1240x1240px. Pediatric retinal photograph (wide-field). Phoenix ICON, 100° FOV — 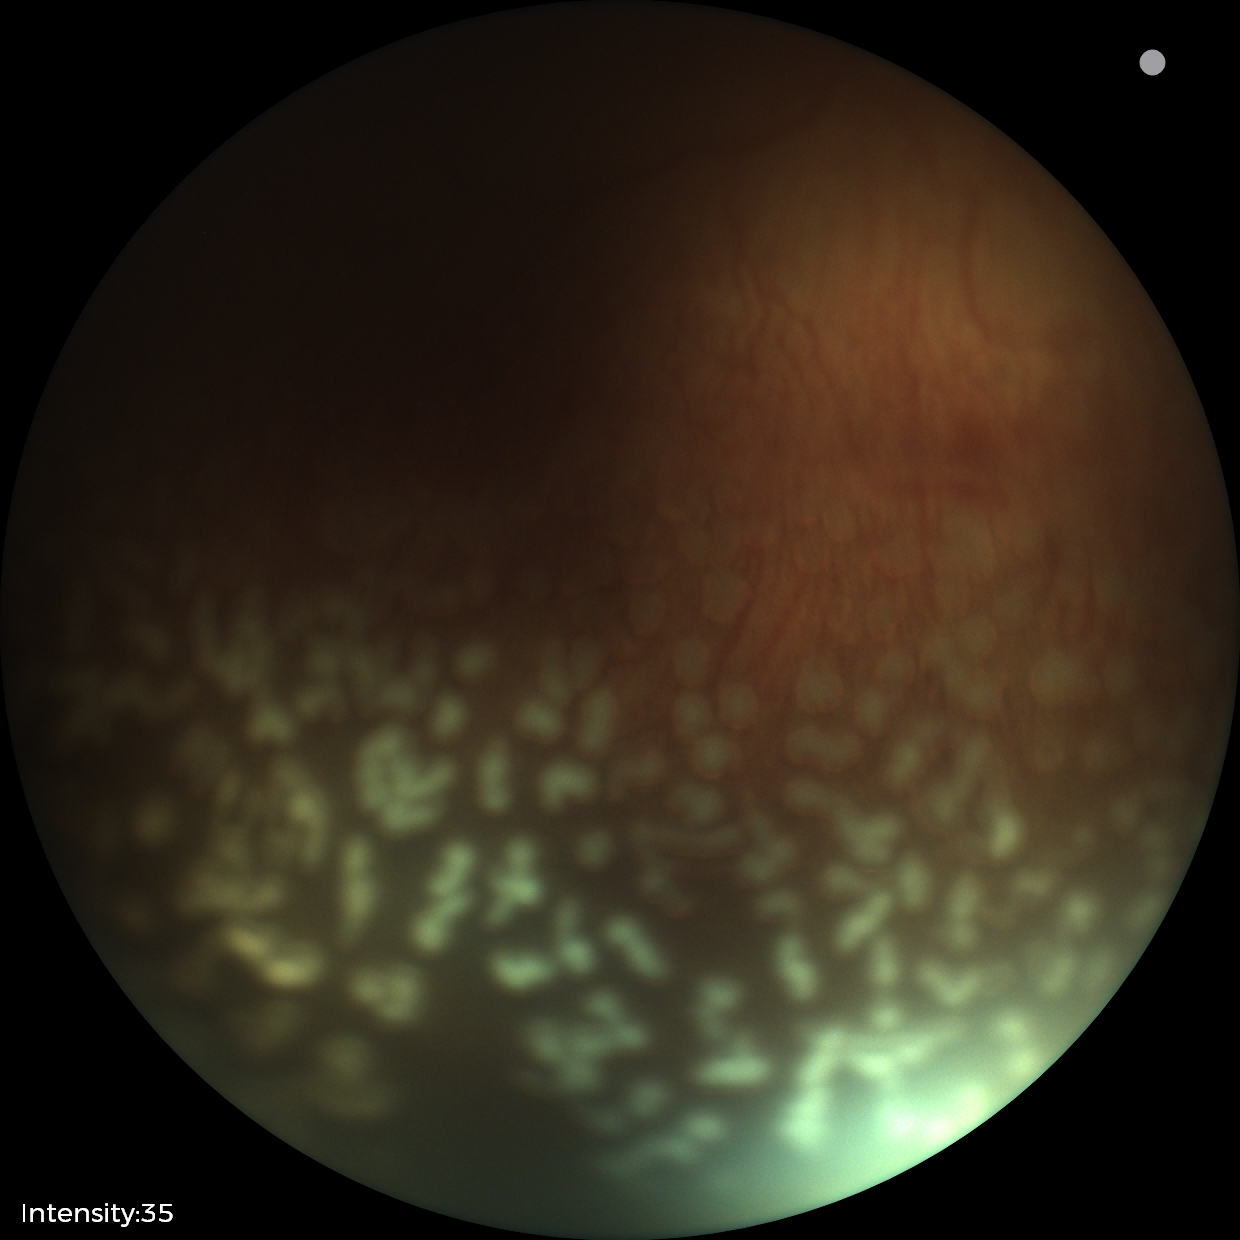 Screening examination consistent with ROP stage 2.
Plus disease was diagnosed.